Wide-field fundus photograph from neonatal ROP screening: 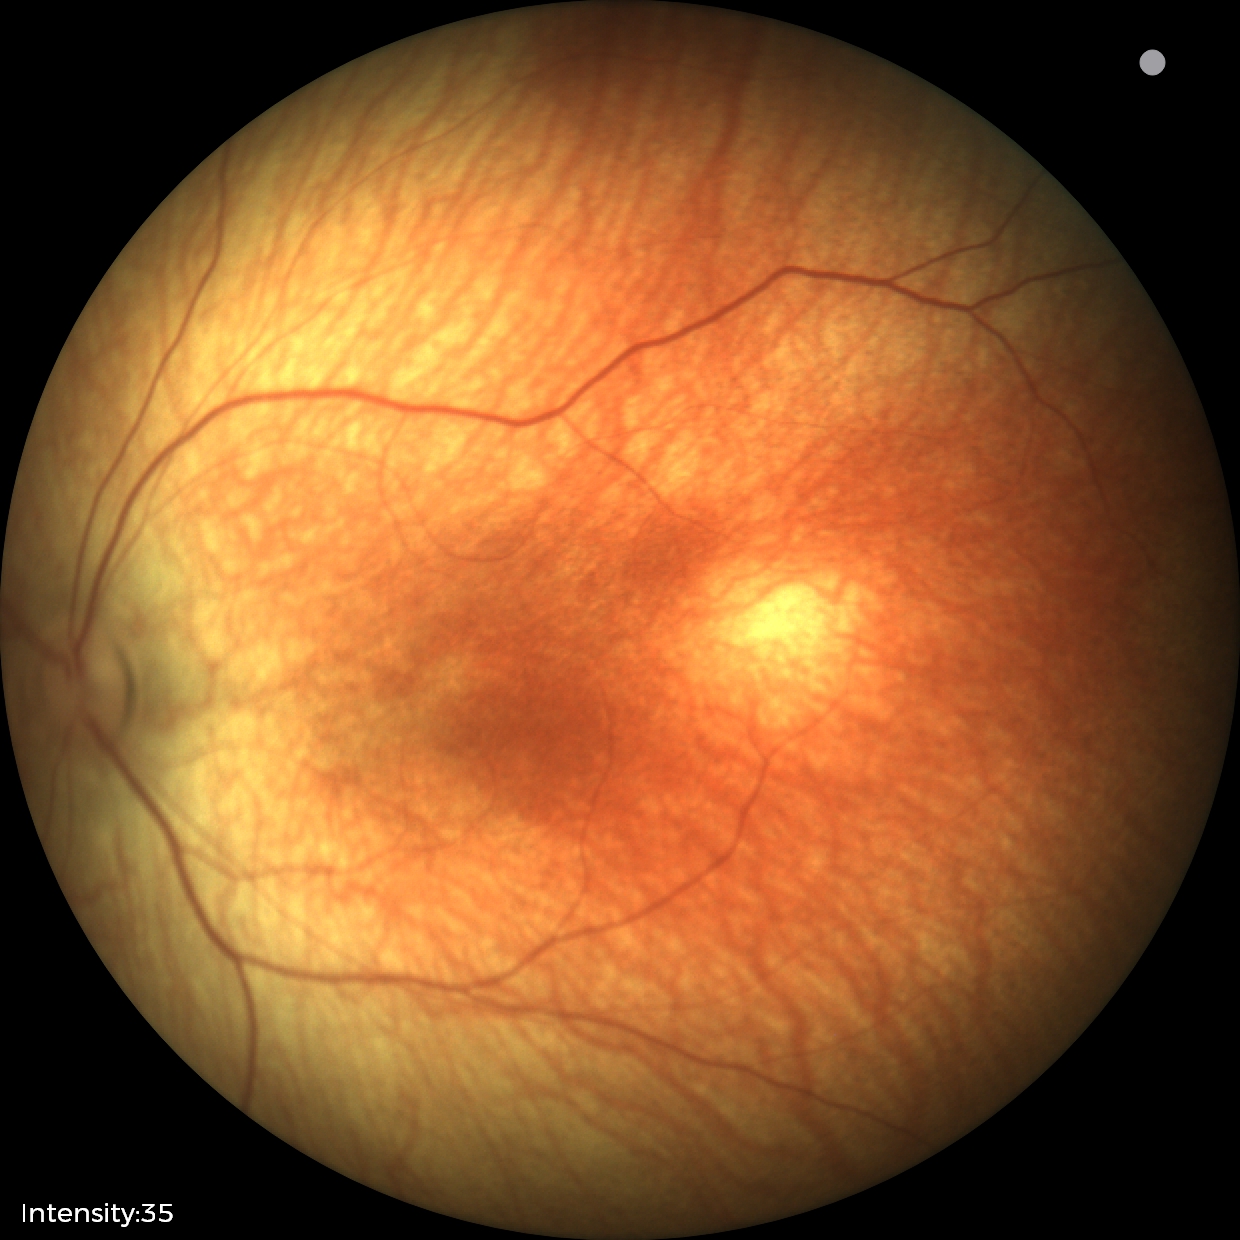 Screening examination diagnosed as physiological.